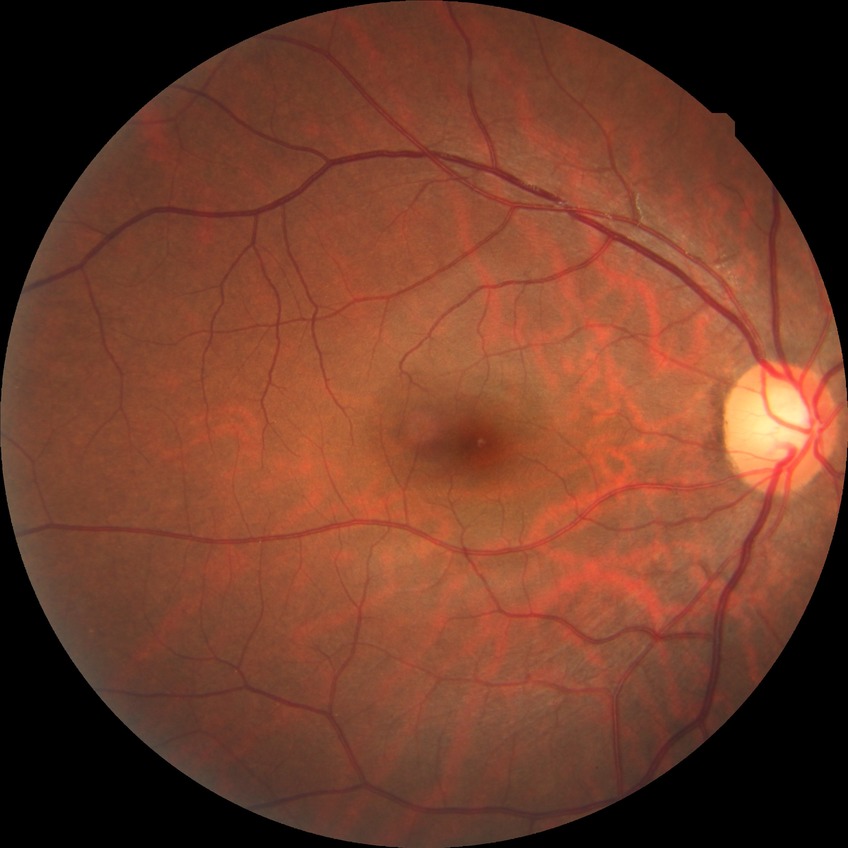 Diabetic retinopathy (DR) is no diabetic retinopathy (NDR).